CFP:
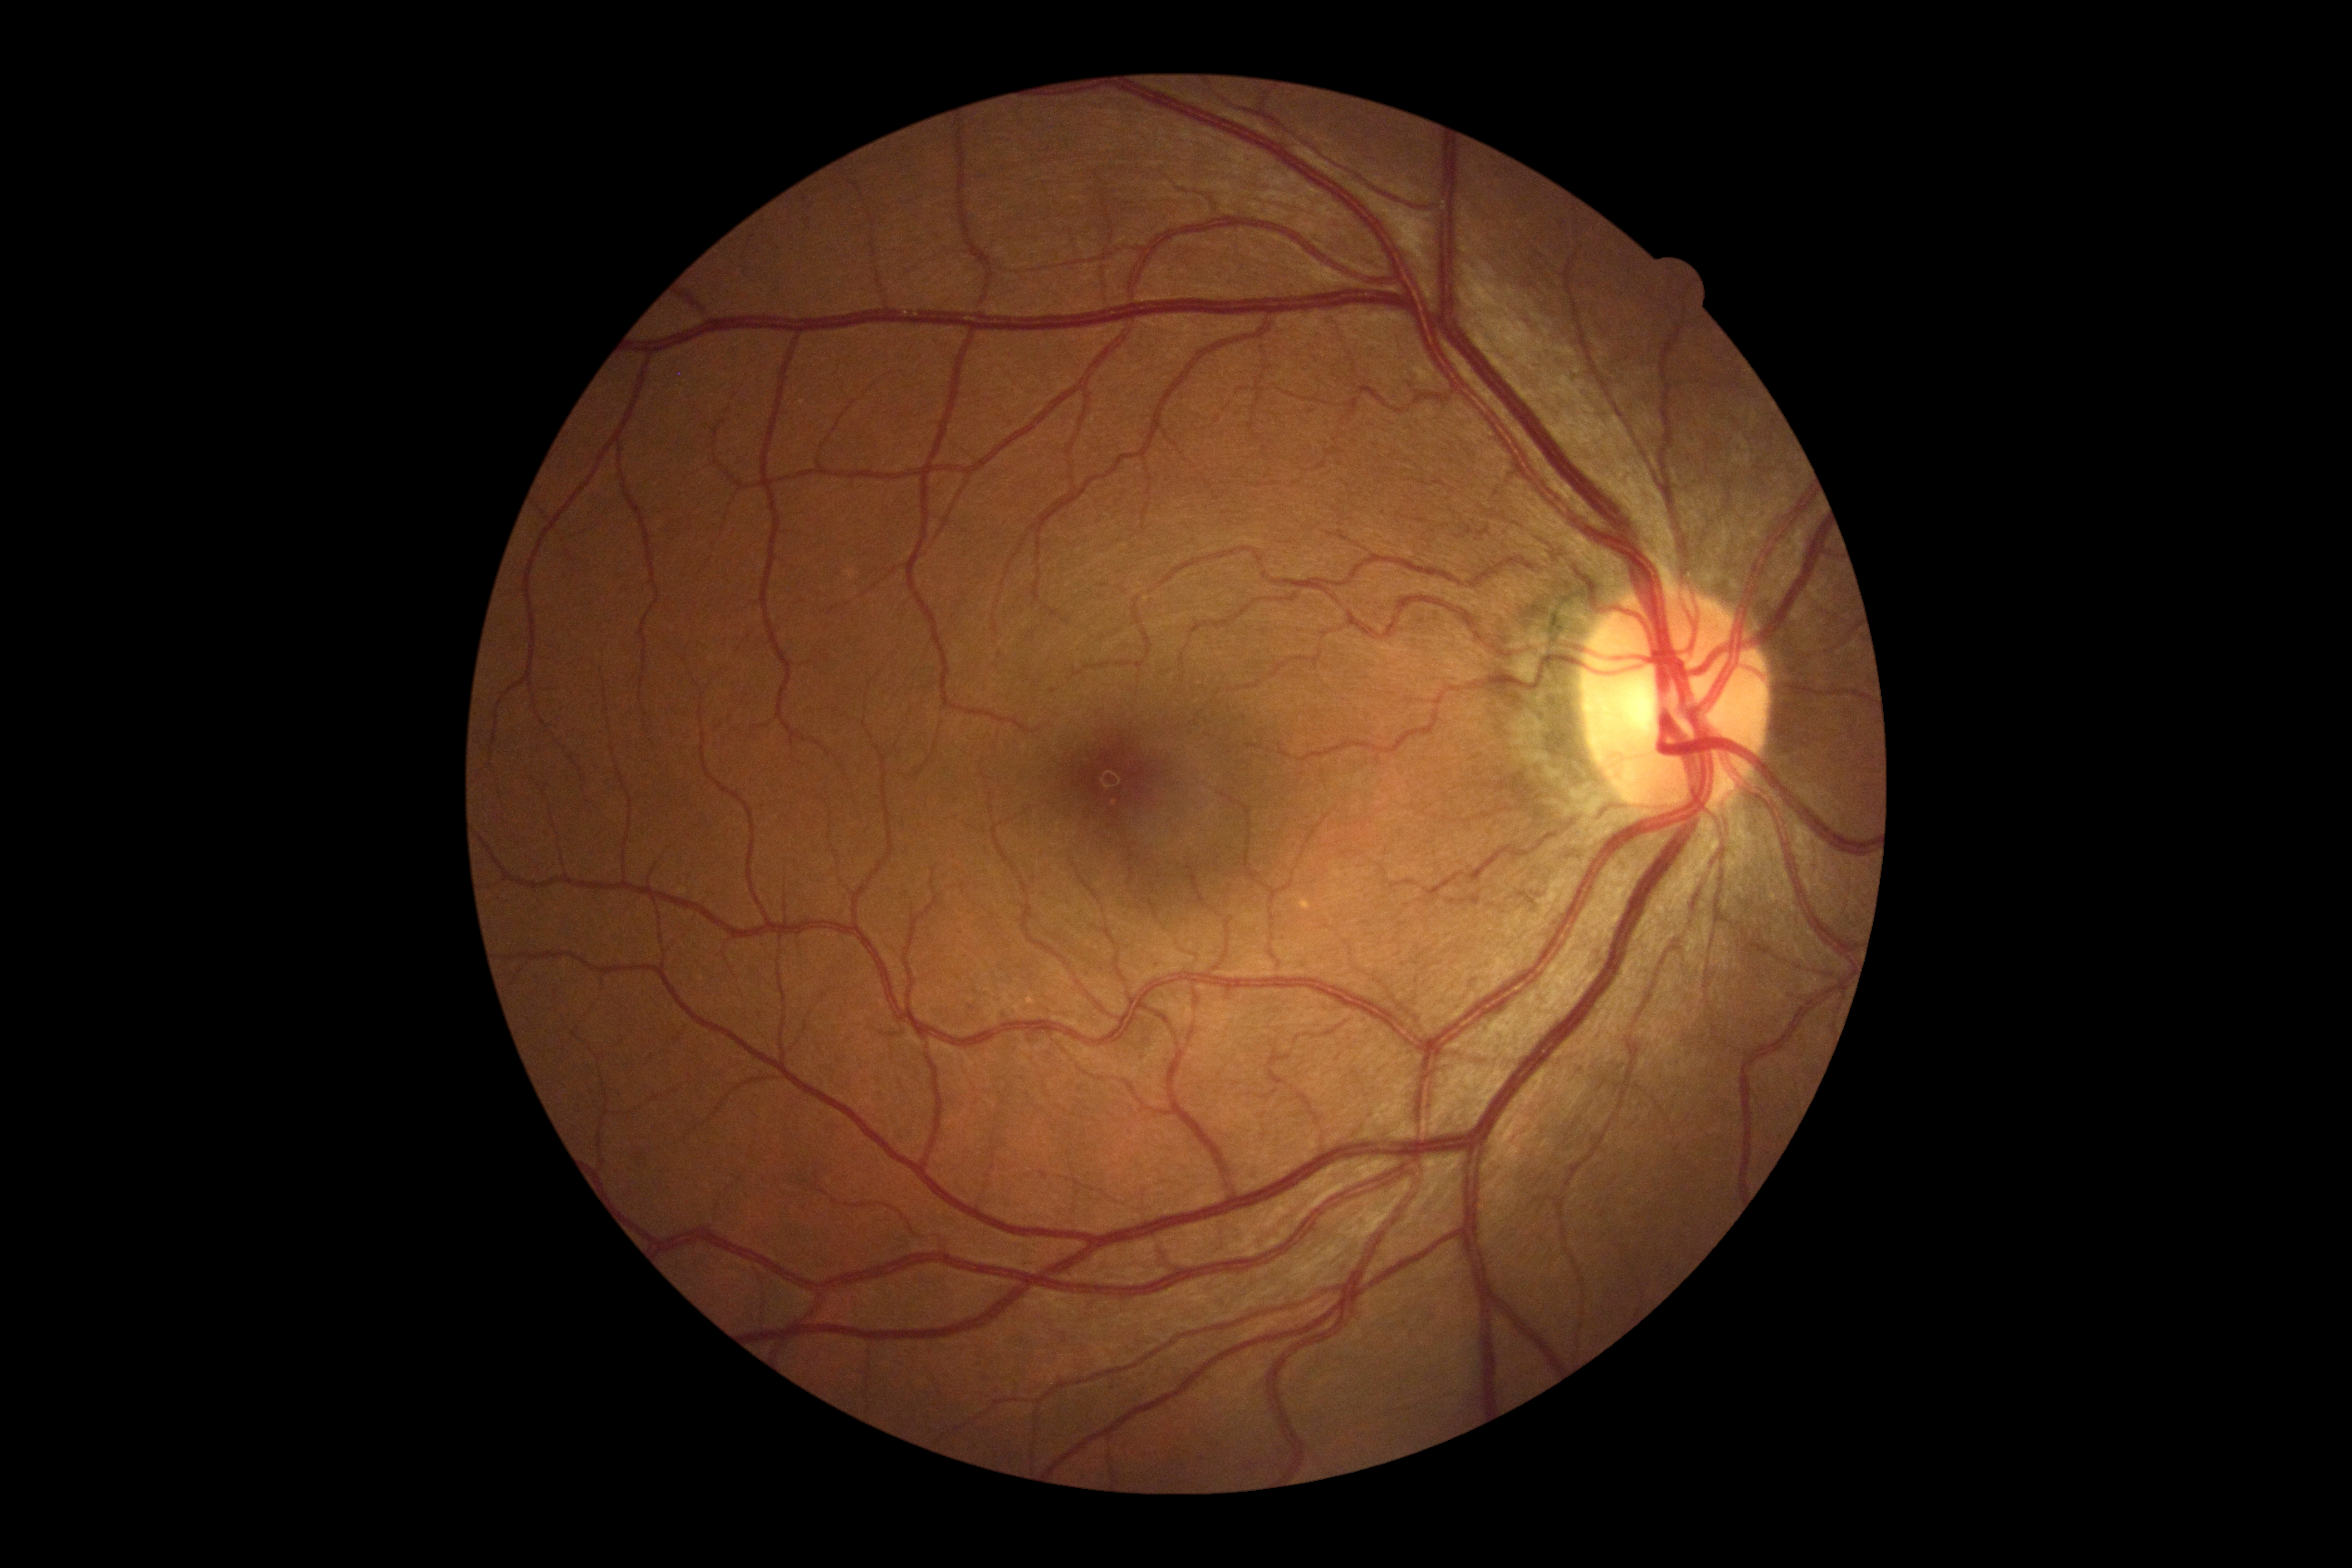

DR impression = no DR findings
diabetic retinopathy (DR) = grade 0 (no apparent retinopathy)